2048x1536px.
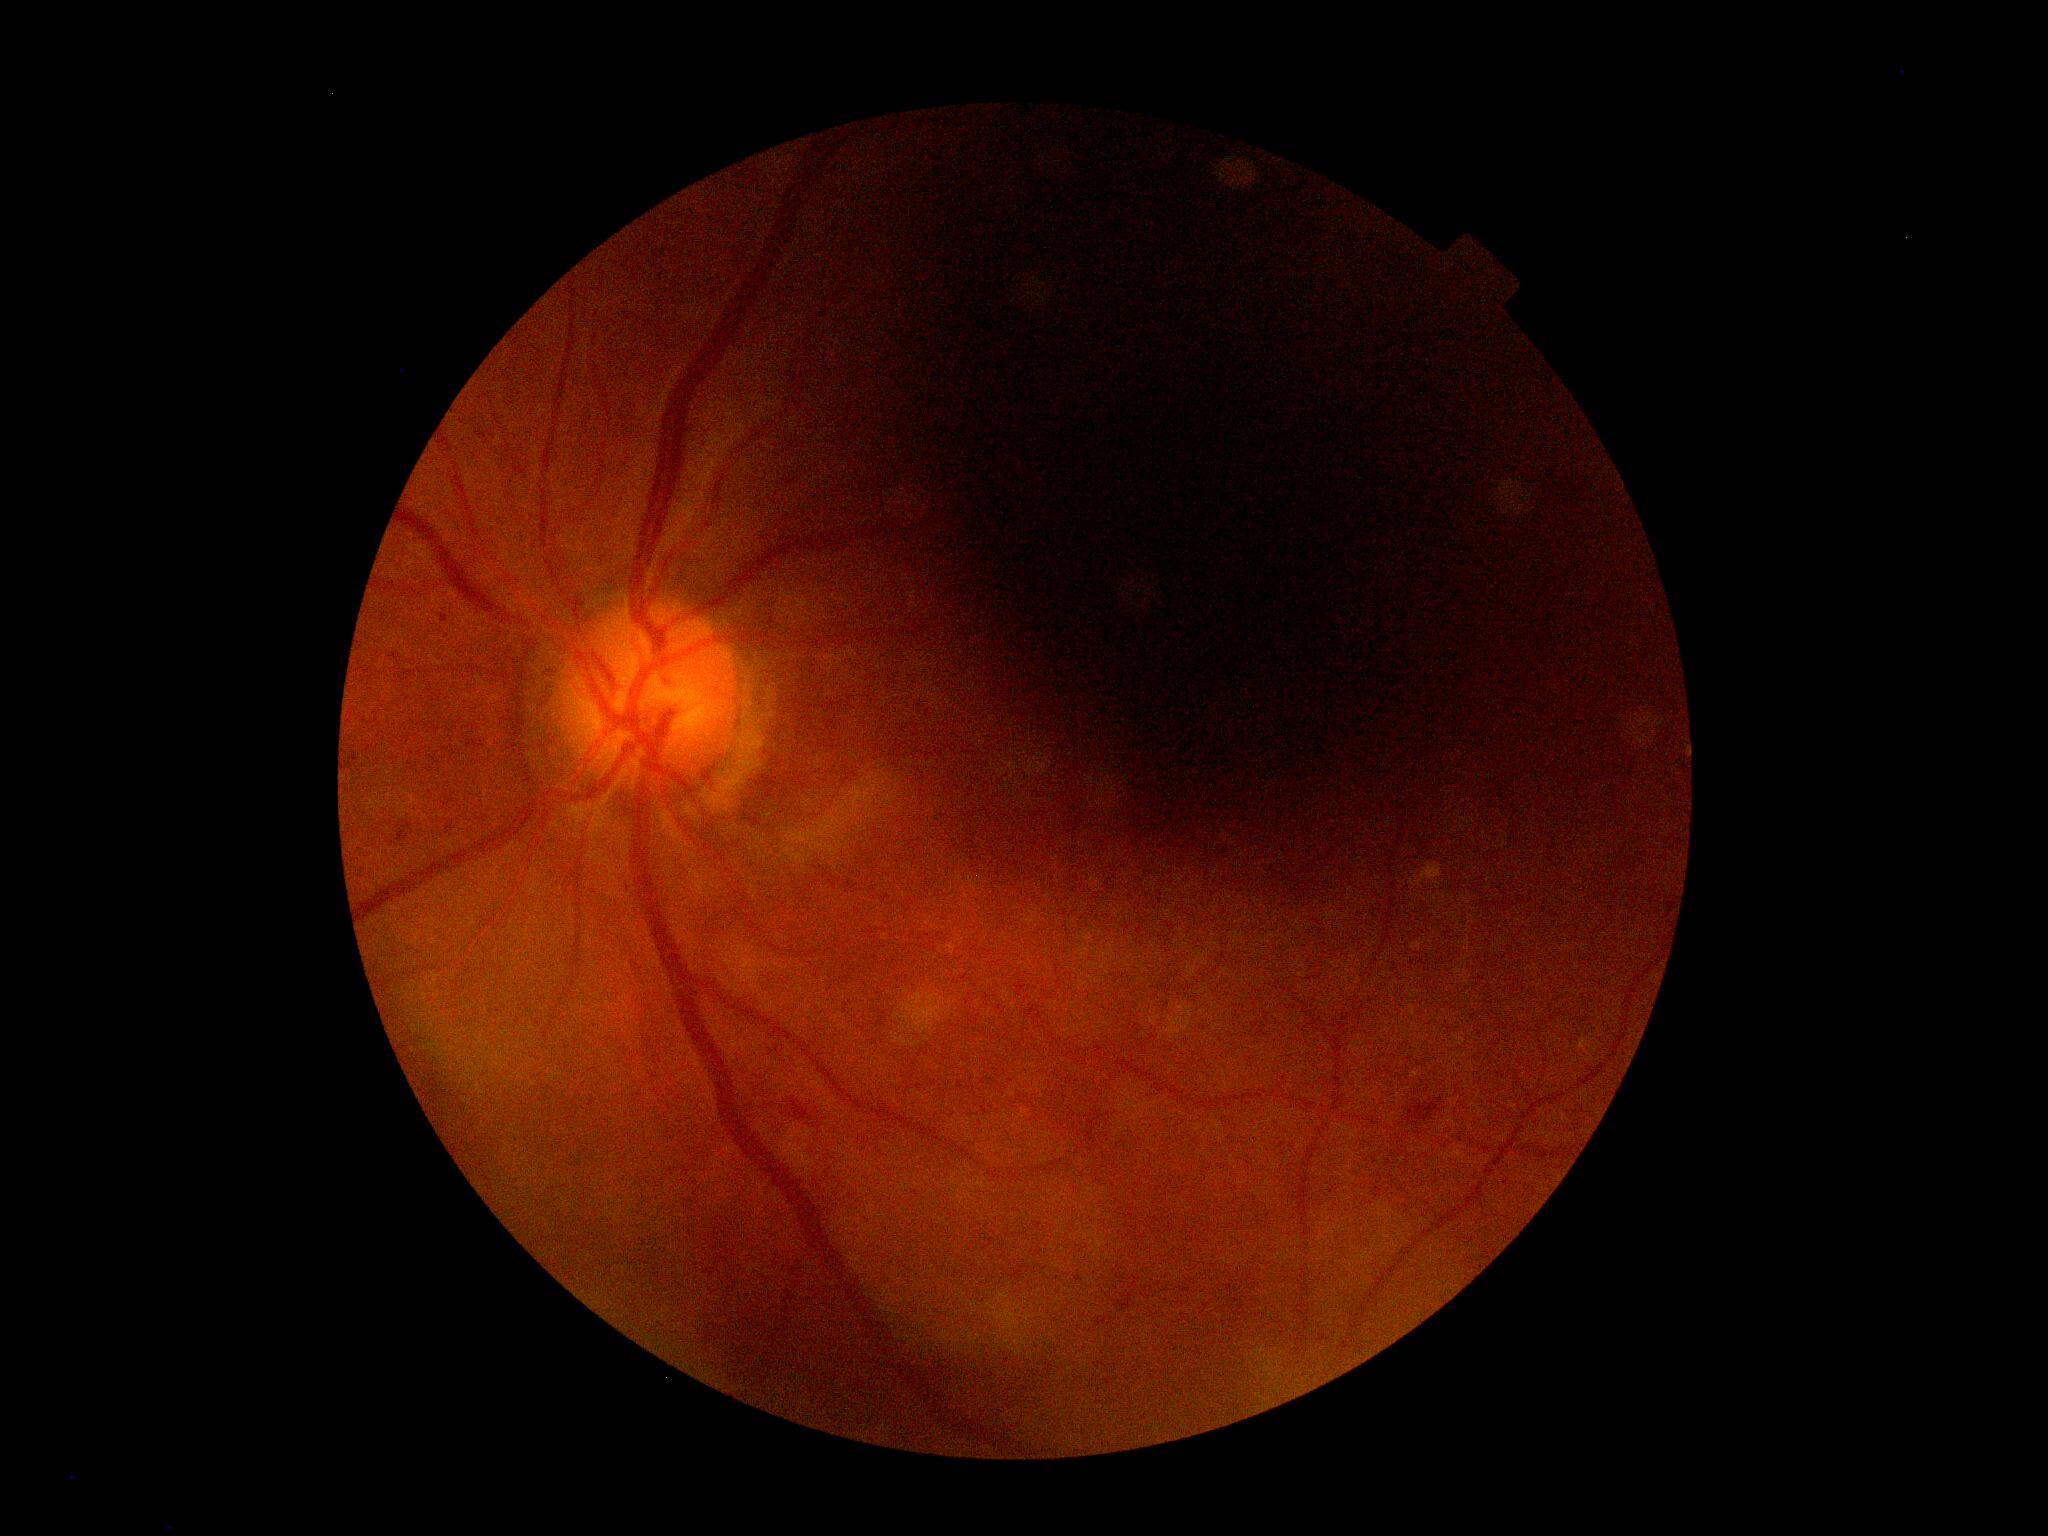
Diabetic retinopathy (DR): ungradable.